NIDEK AFC-230, without pupil dilation, FOV: 45 degrees: 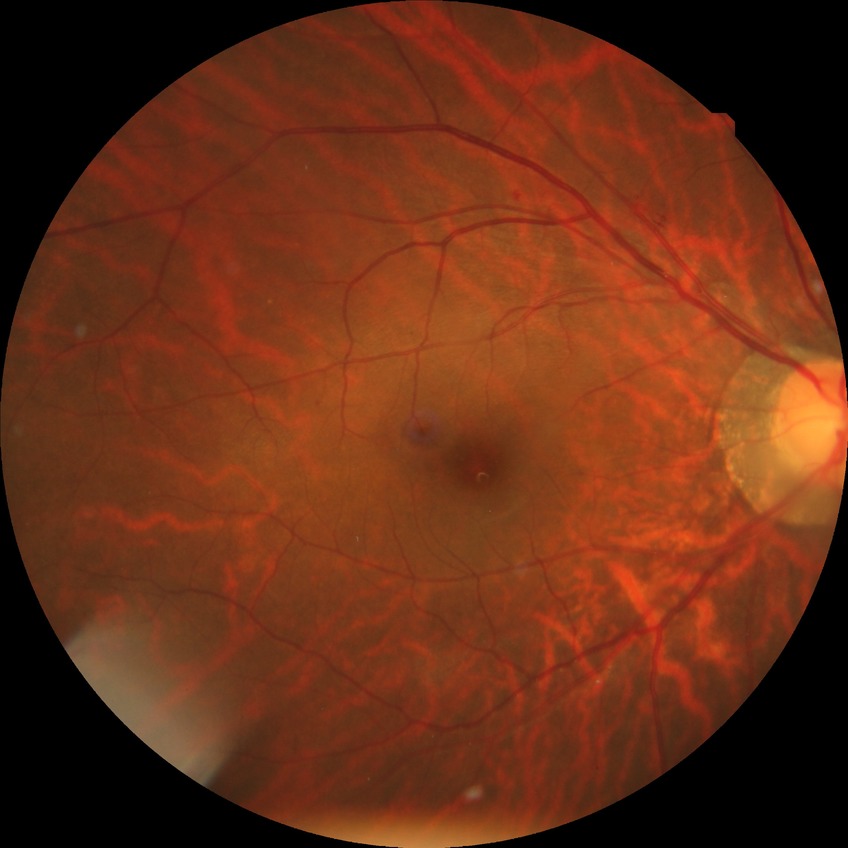

Diabetic retinopathy grade is simple diabetic retinopathy.